Captured with the Clarity RetCam 3 (130° field of view); pediatric wide-field fundus photograph; 640 by 480 pixels
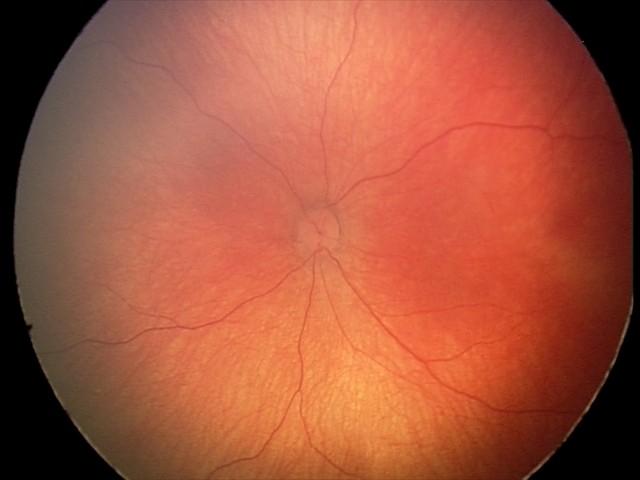 Series diagnosed as retinal hemorrhages.